640x480px · RetCam wide-field infant fundus image · camera: Clarity RetCam 3 (130° FOV):
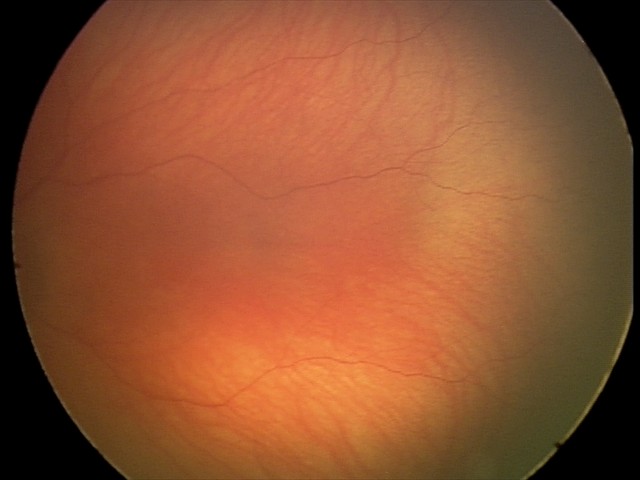 No retinal pathology identified on screening.